1240 x 1240 pixels; wide-field fundus image from infant ROP screening — 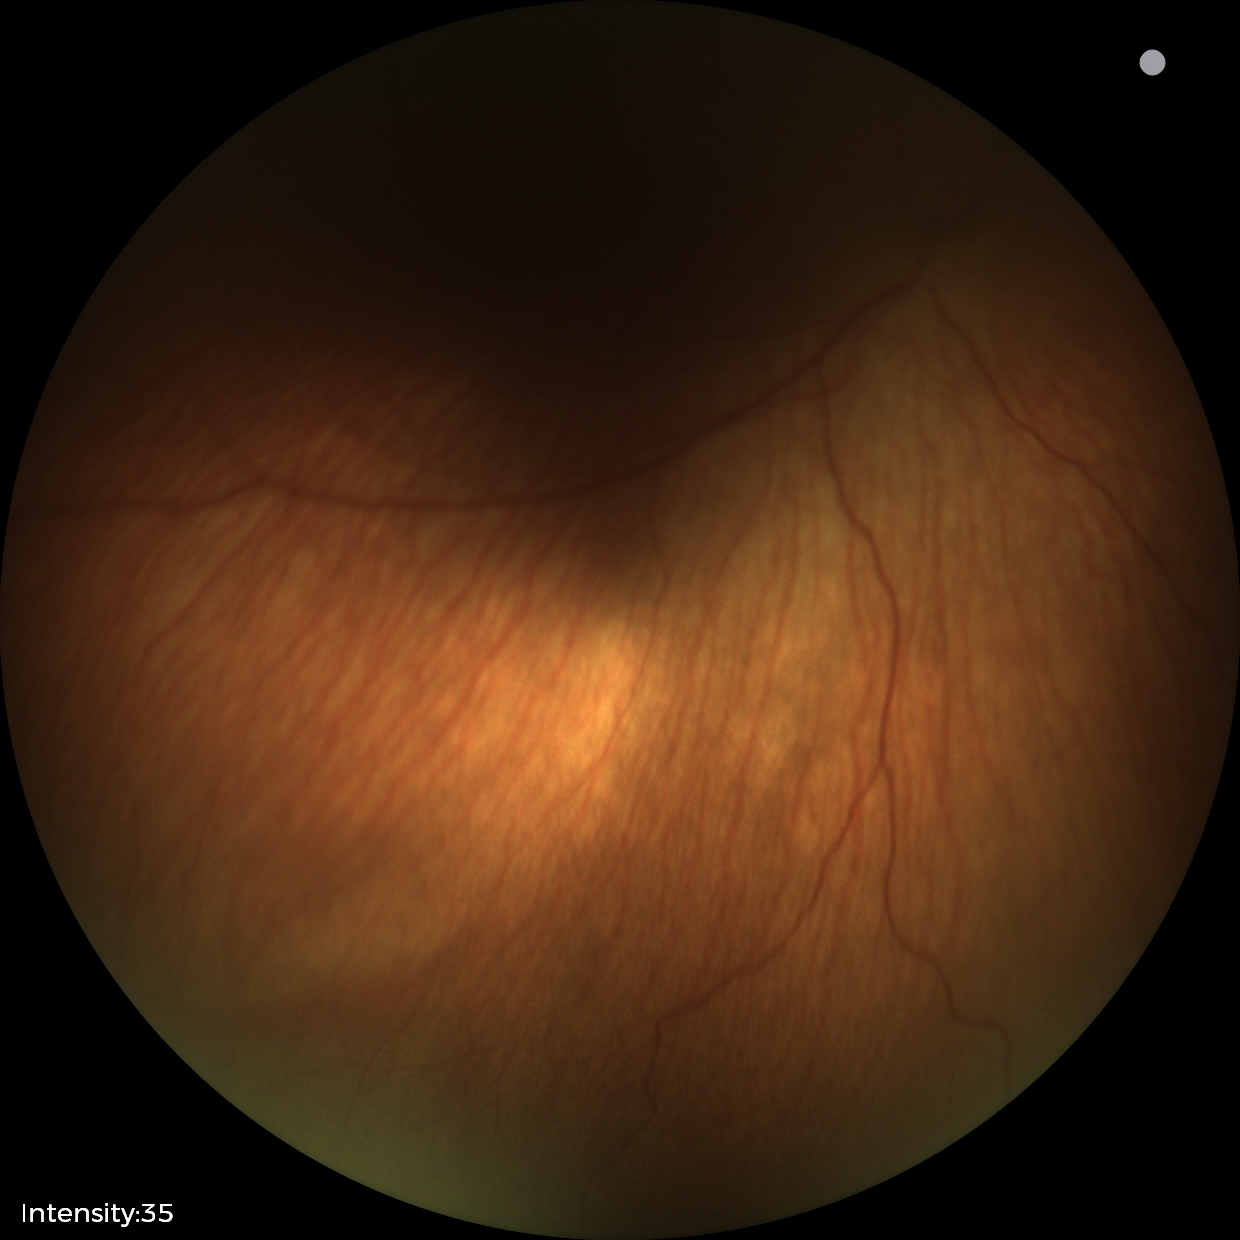

Without plus disease. Screening examination consistent with status post ROP.